2352 x 1568 pixels · color fundus photograph.
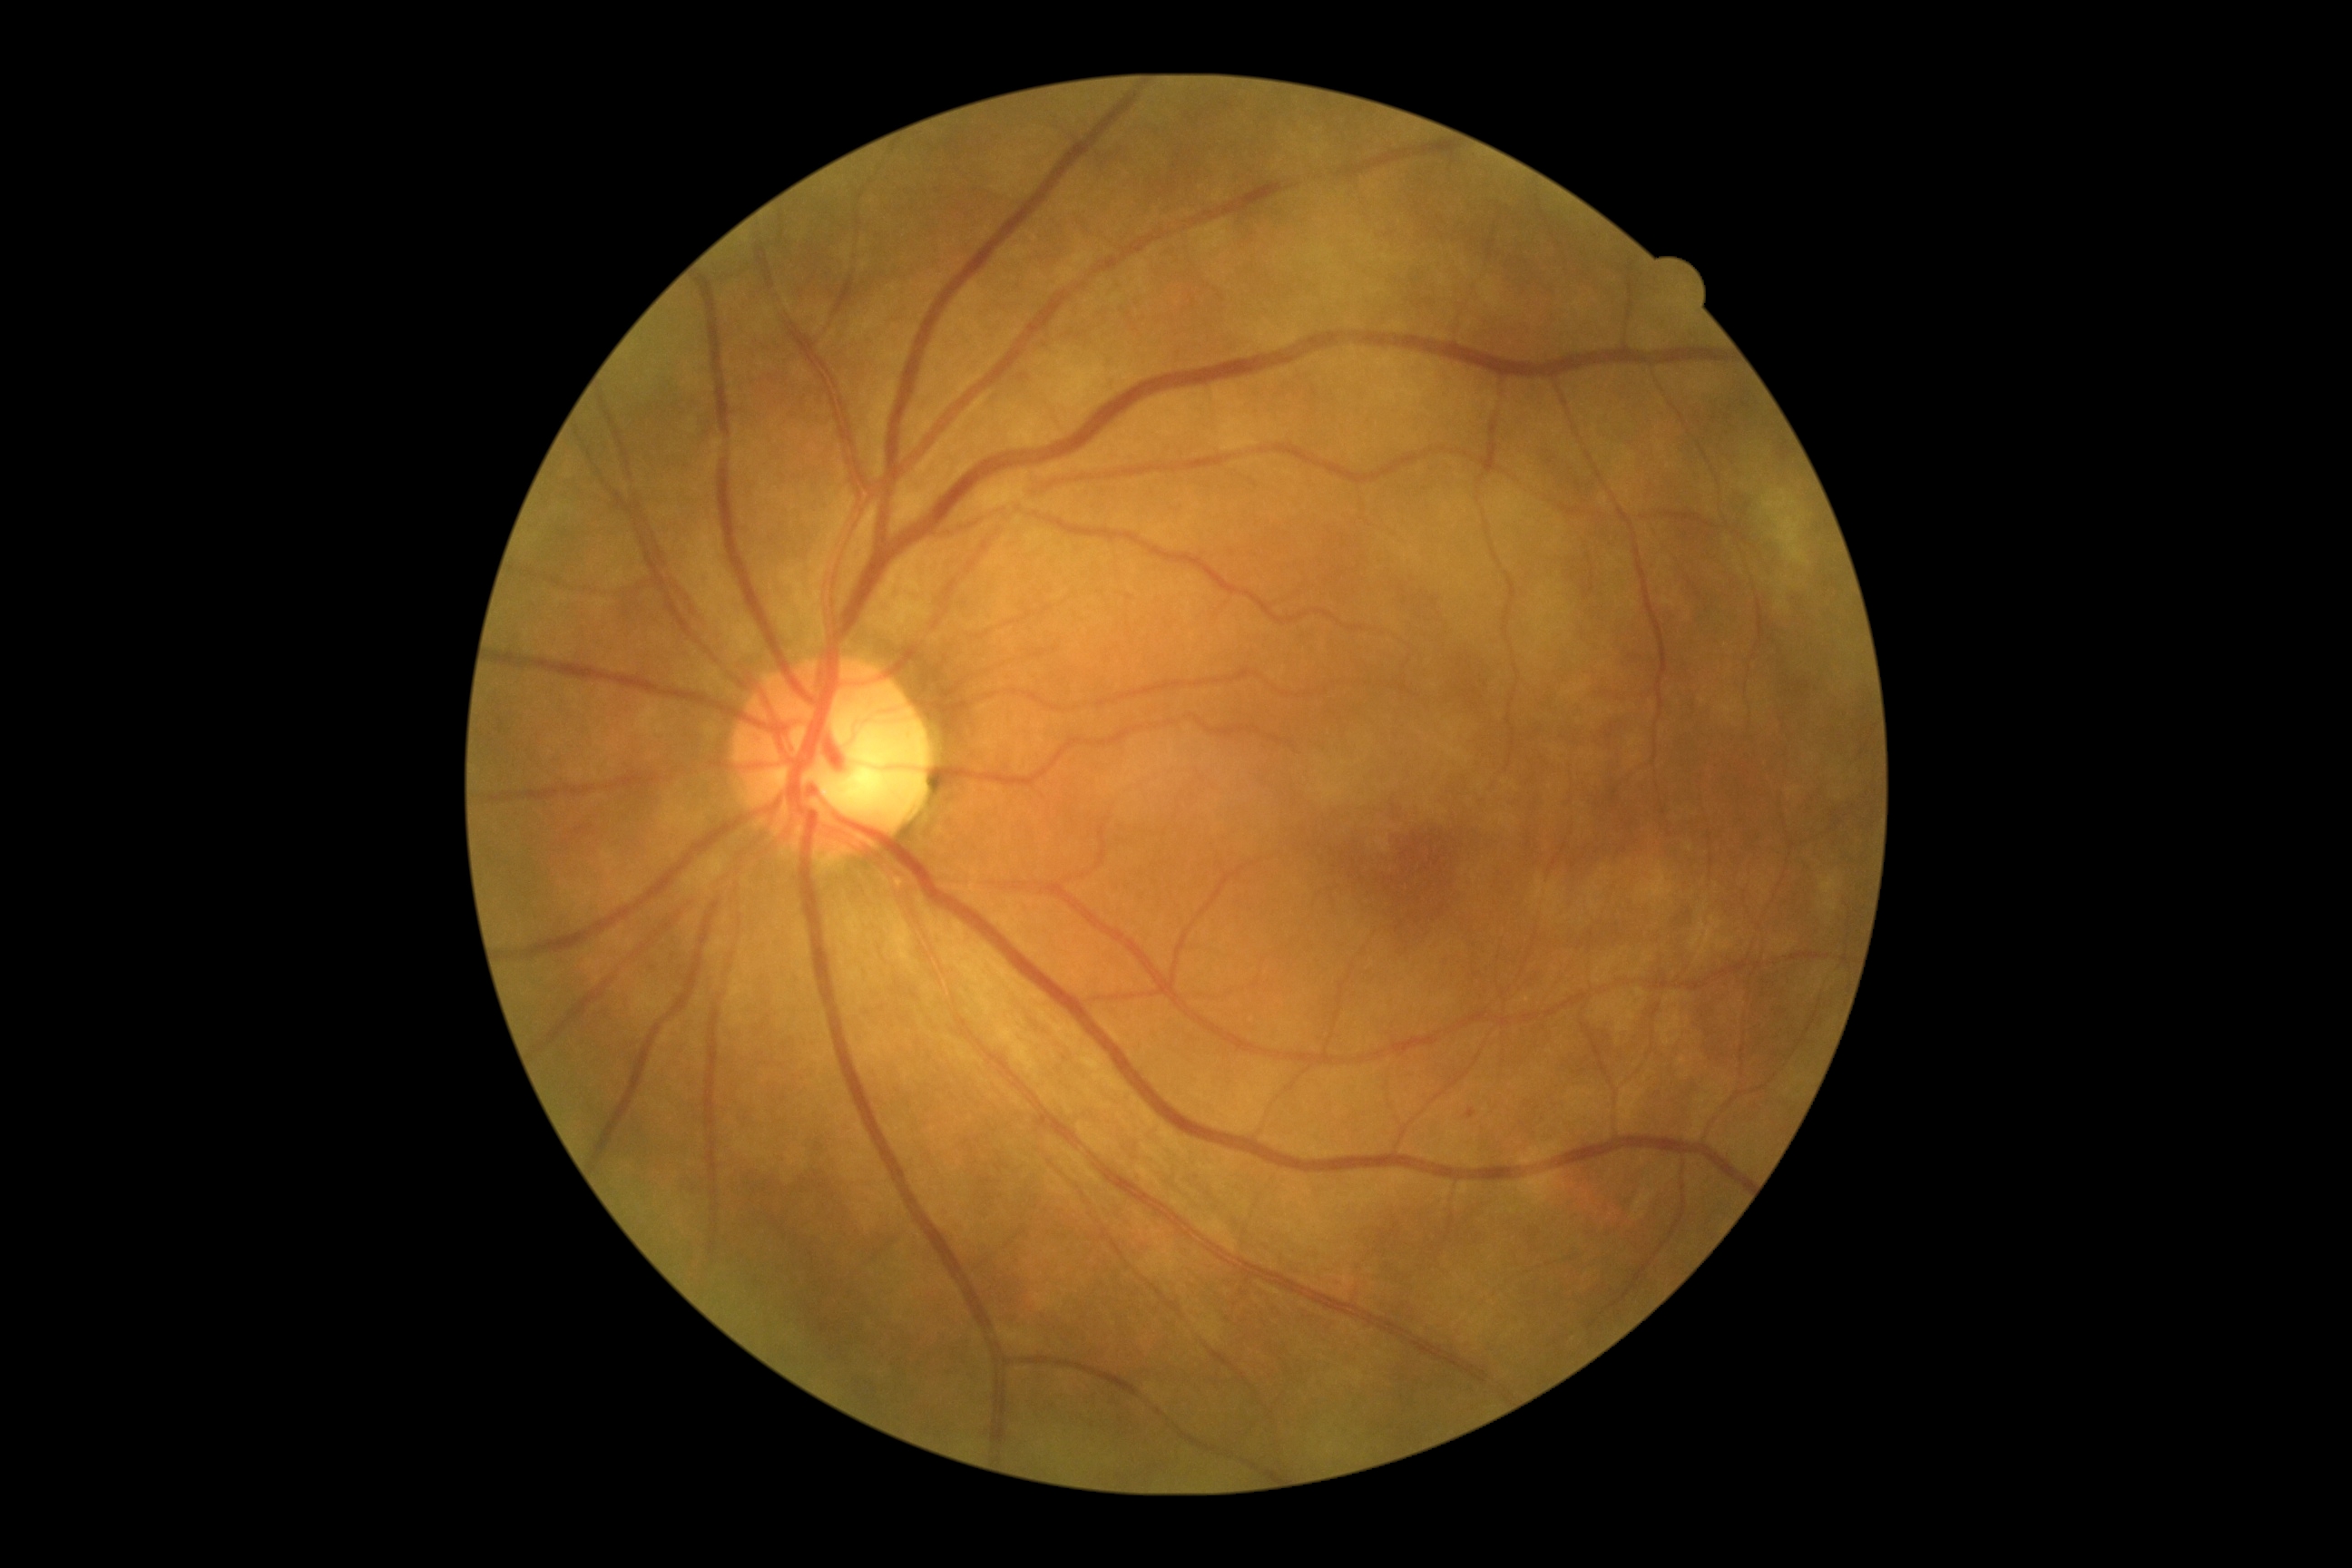
  dr_grade: mild non-proliferative diabetic retinopathy (grade 1)